Graded on the modified Davis scale:
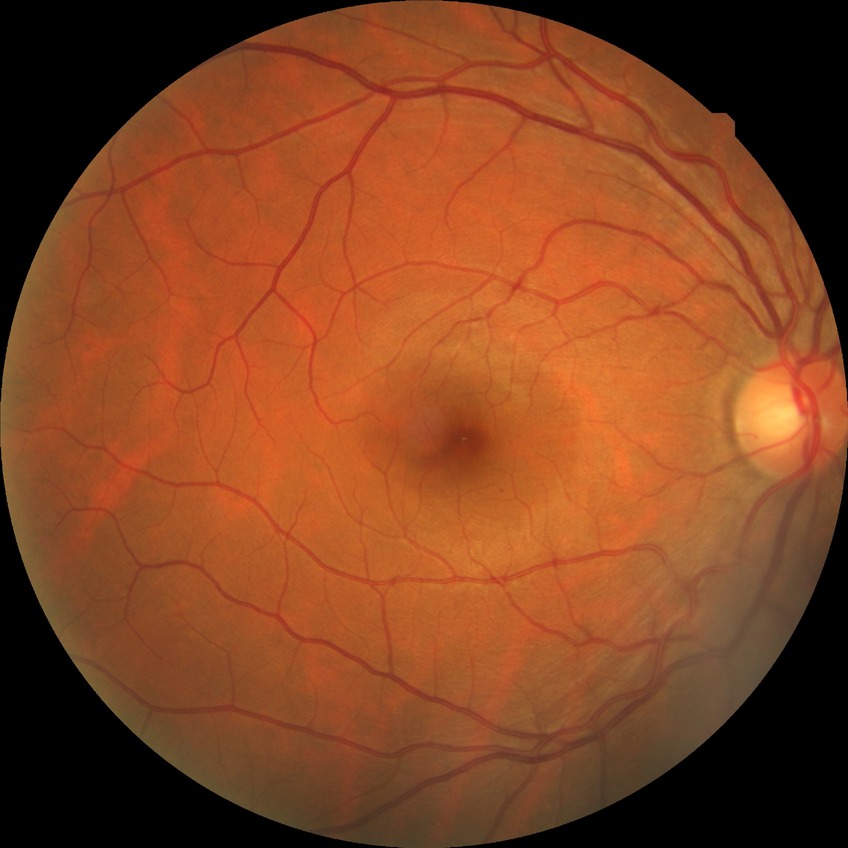 Retinopathy stage: no diabetic retinopathy.